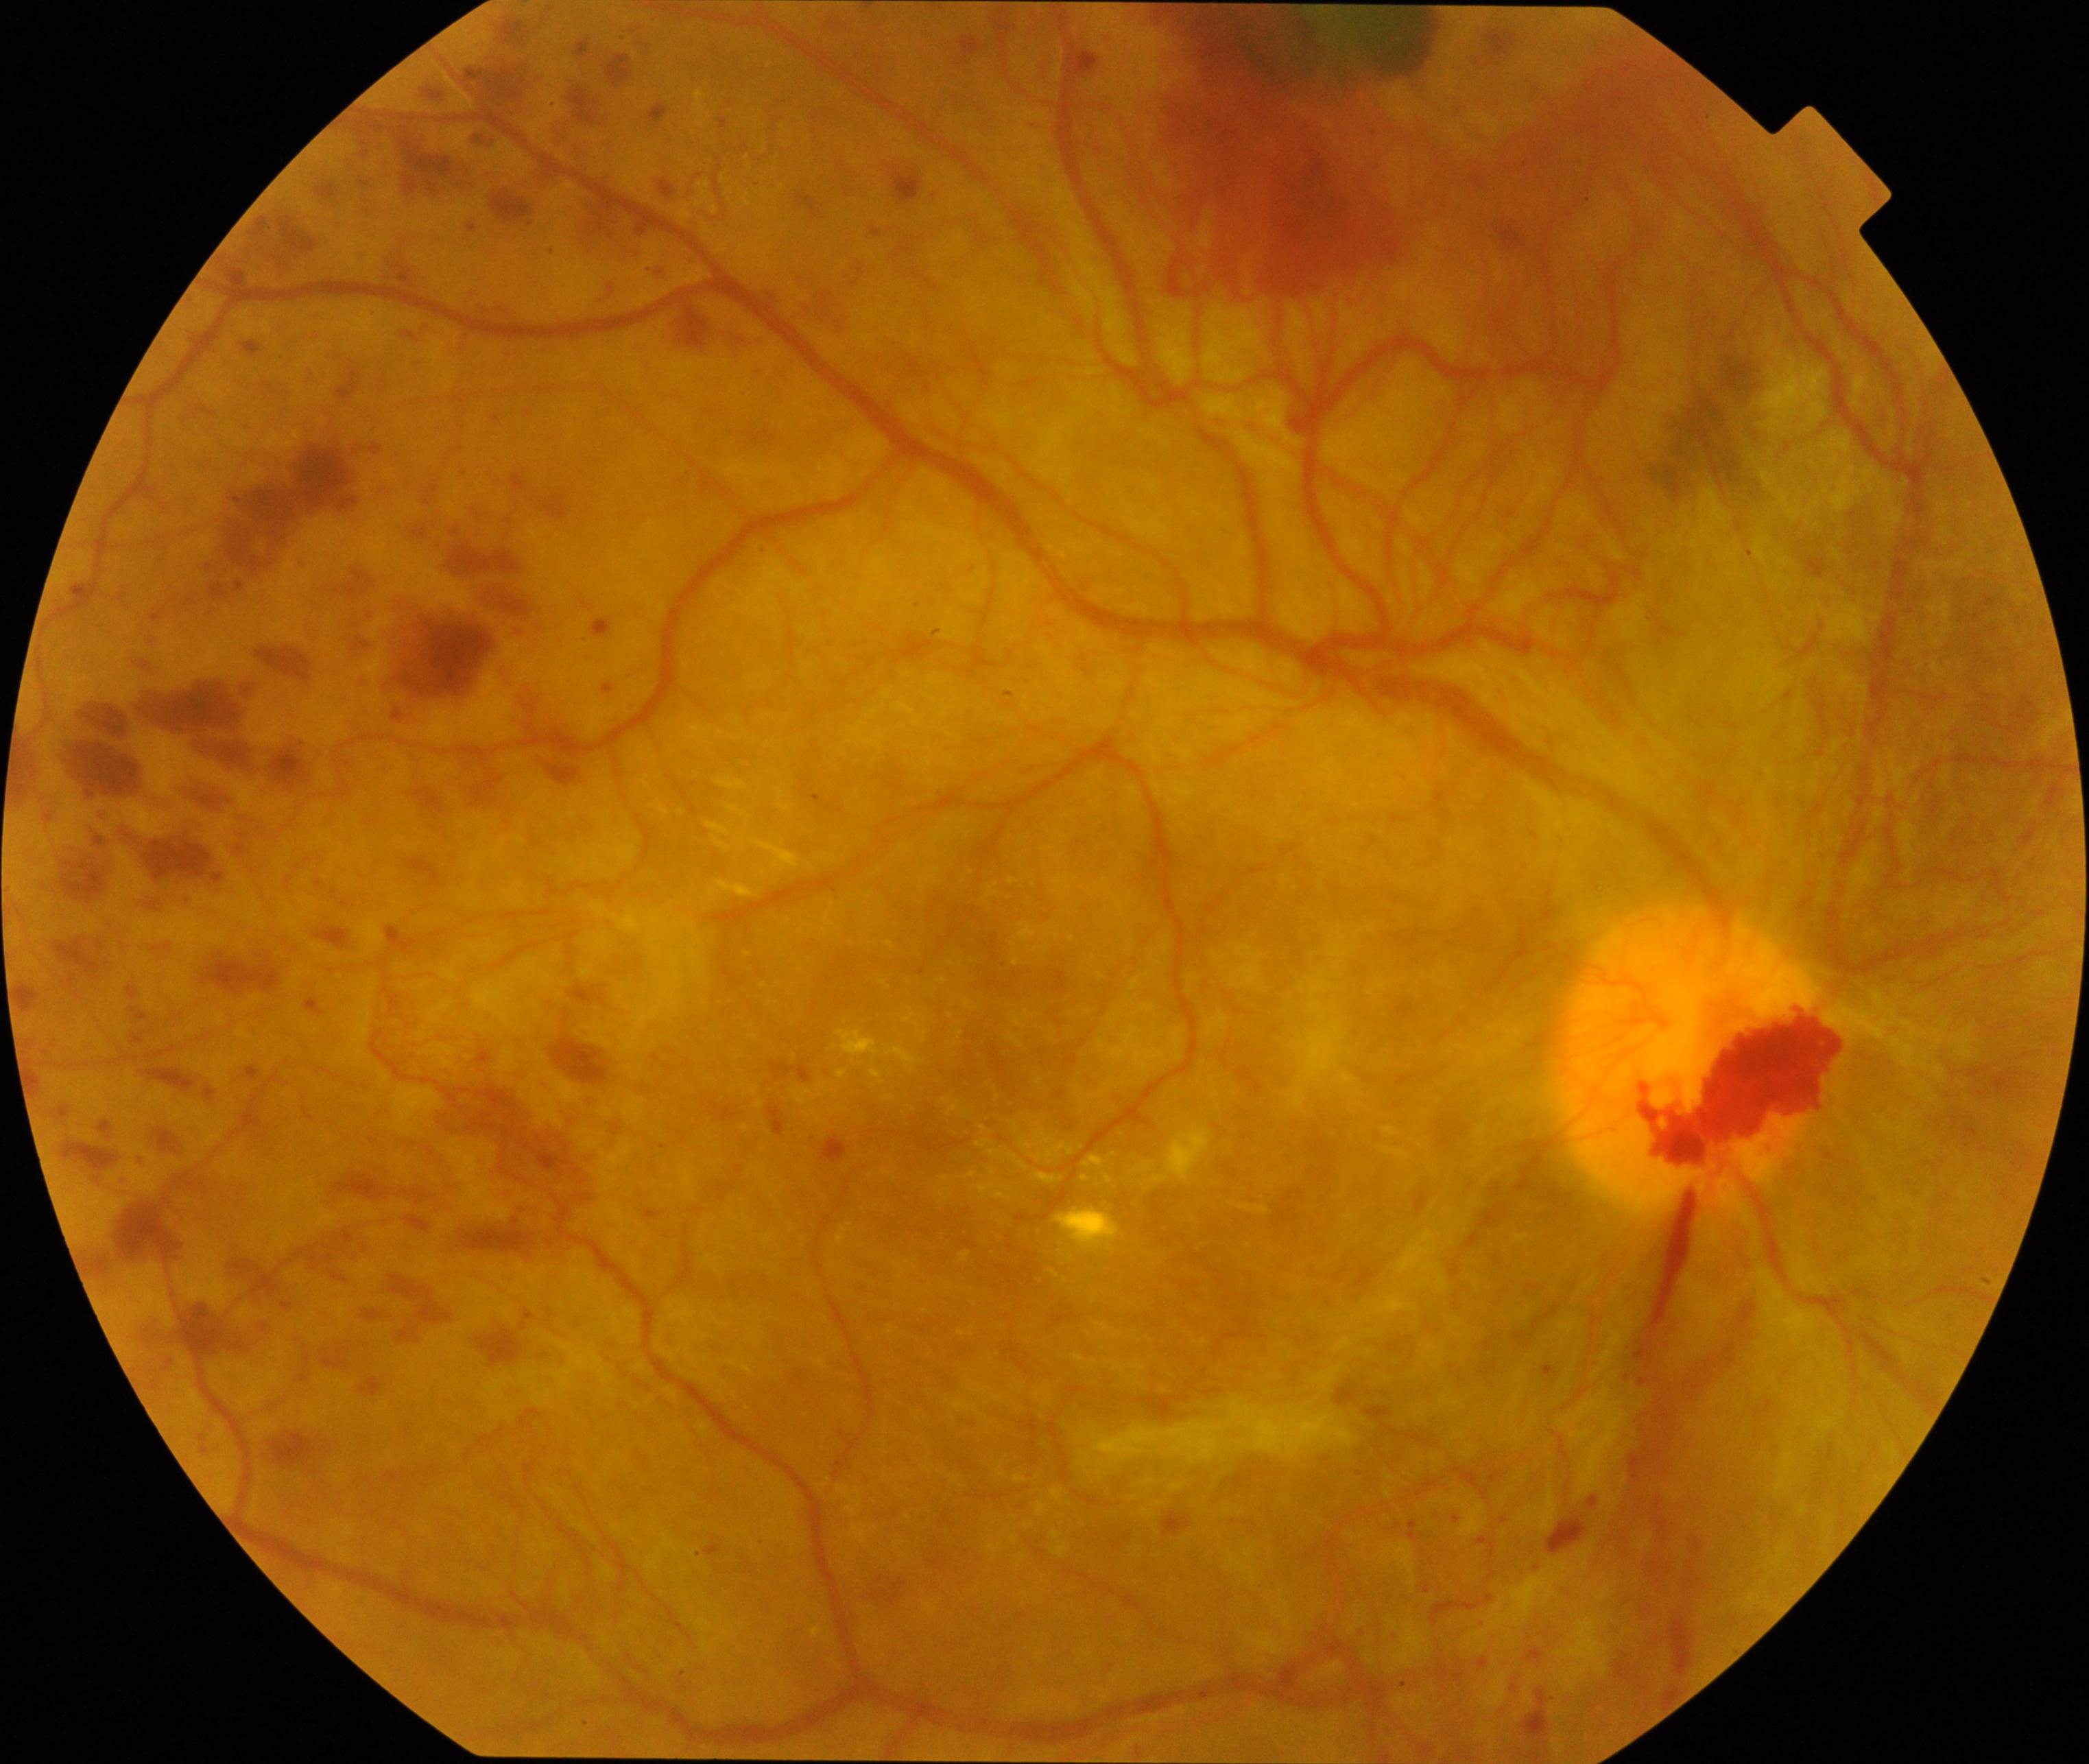
Impression: severe non-proliferative or proliferative diabetic retinopathy.